NIDEK AFC-230
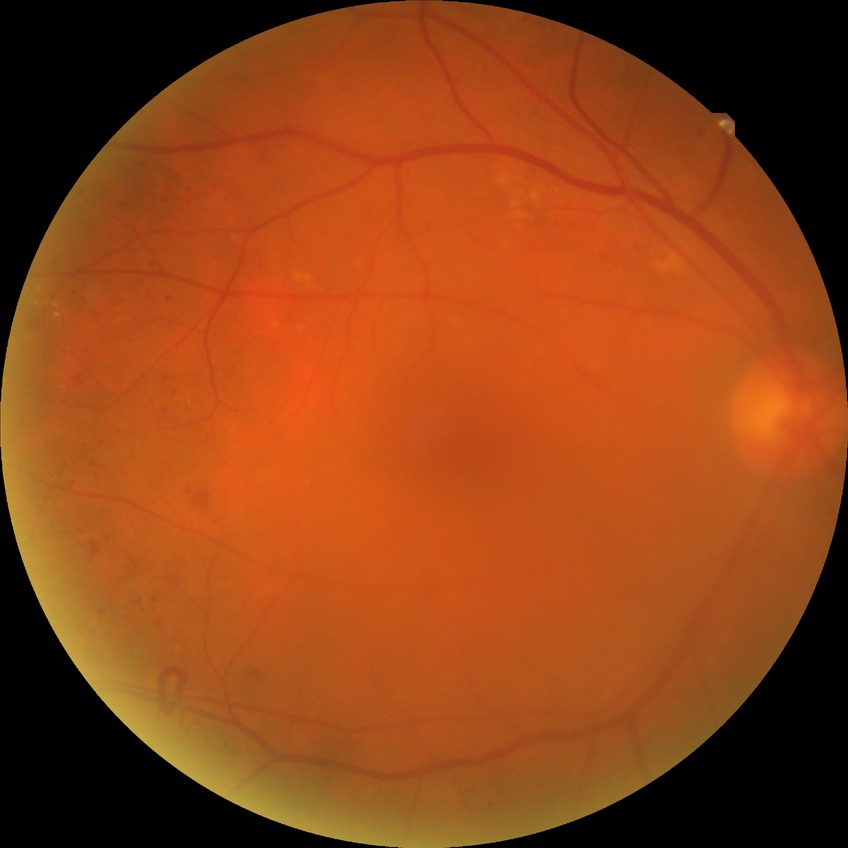
diabetic retinopathy (DR) = simple diabetic retinopathy (SDR).